45° FOV — 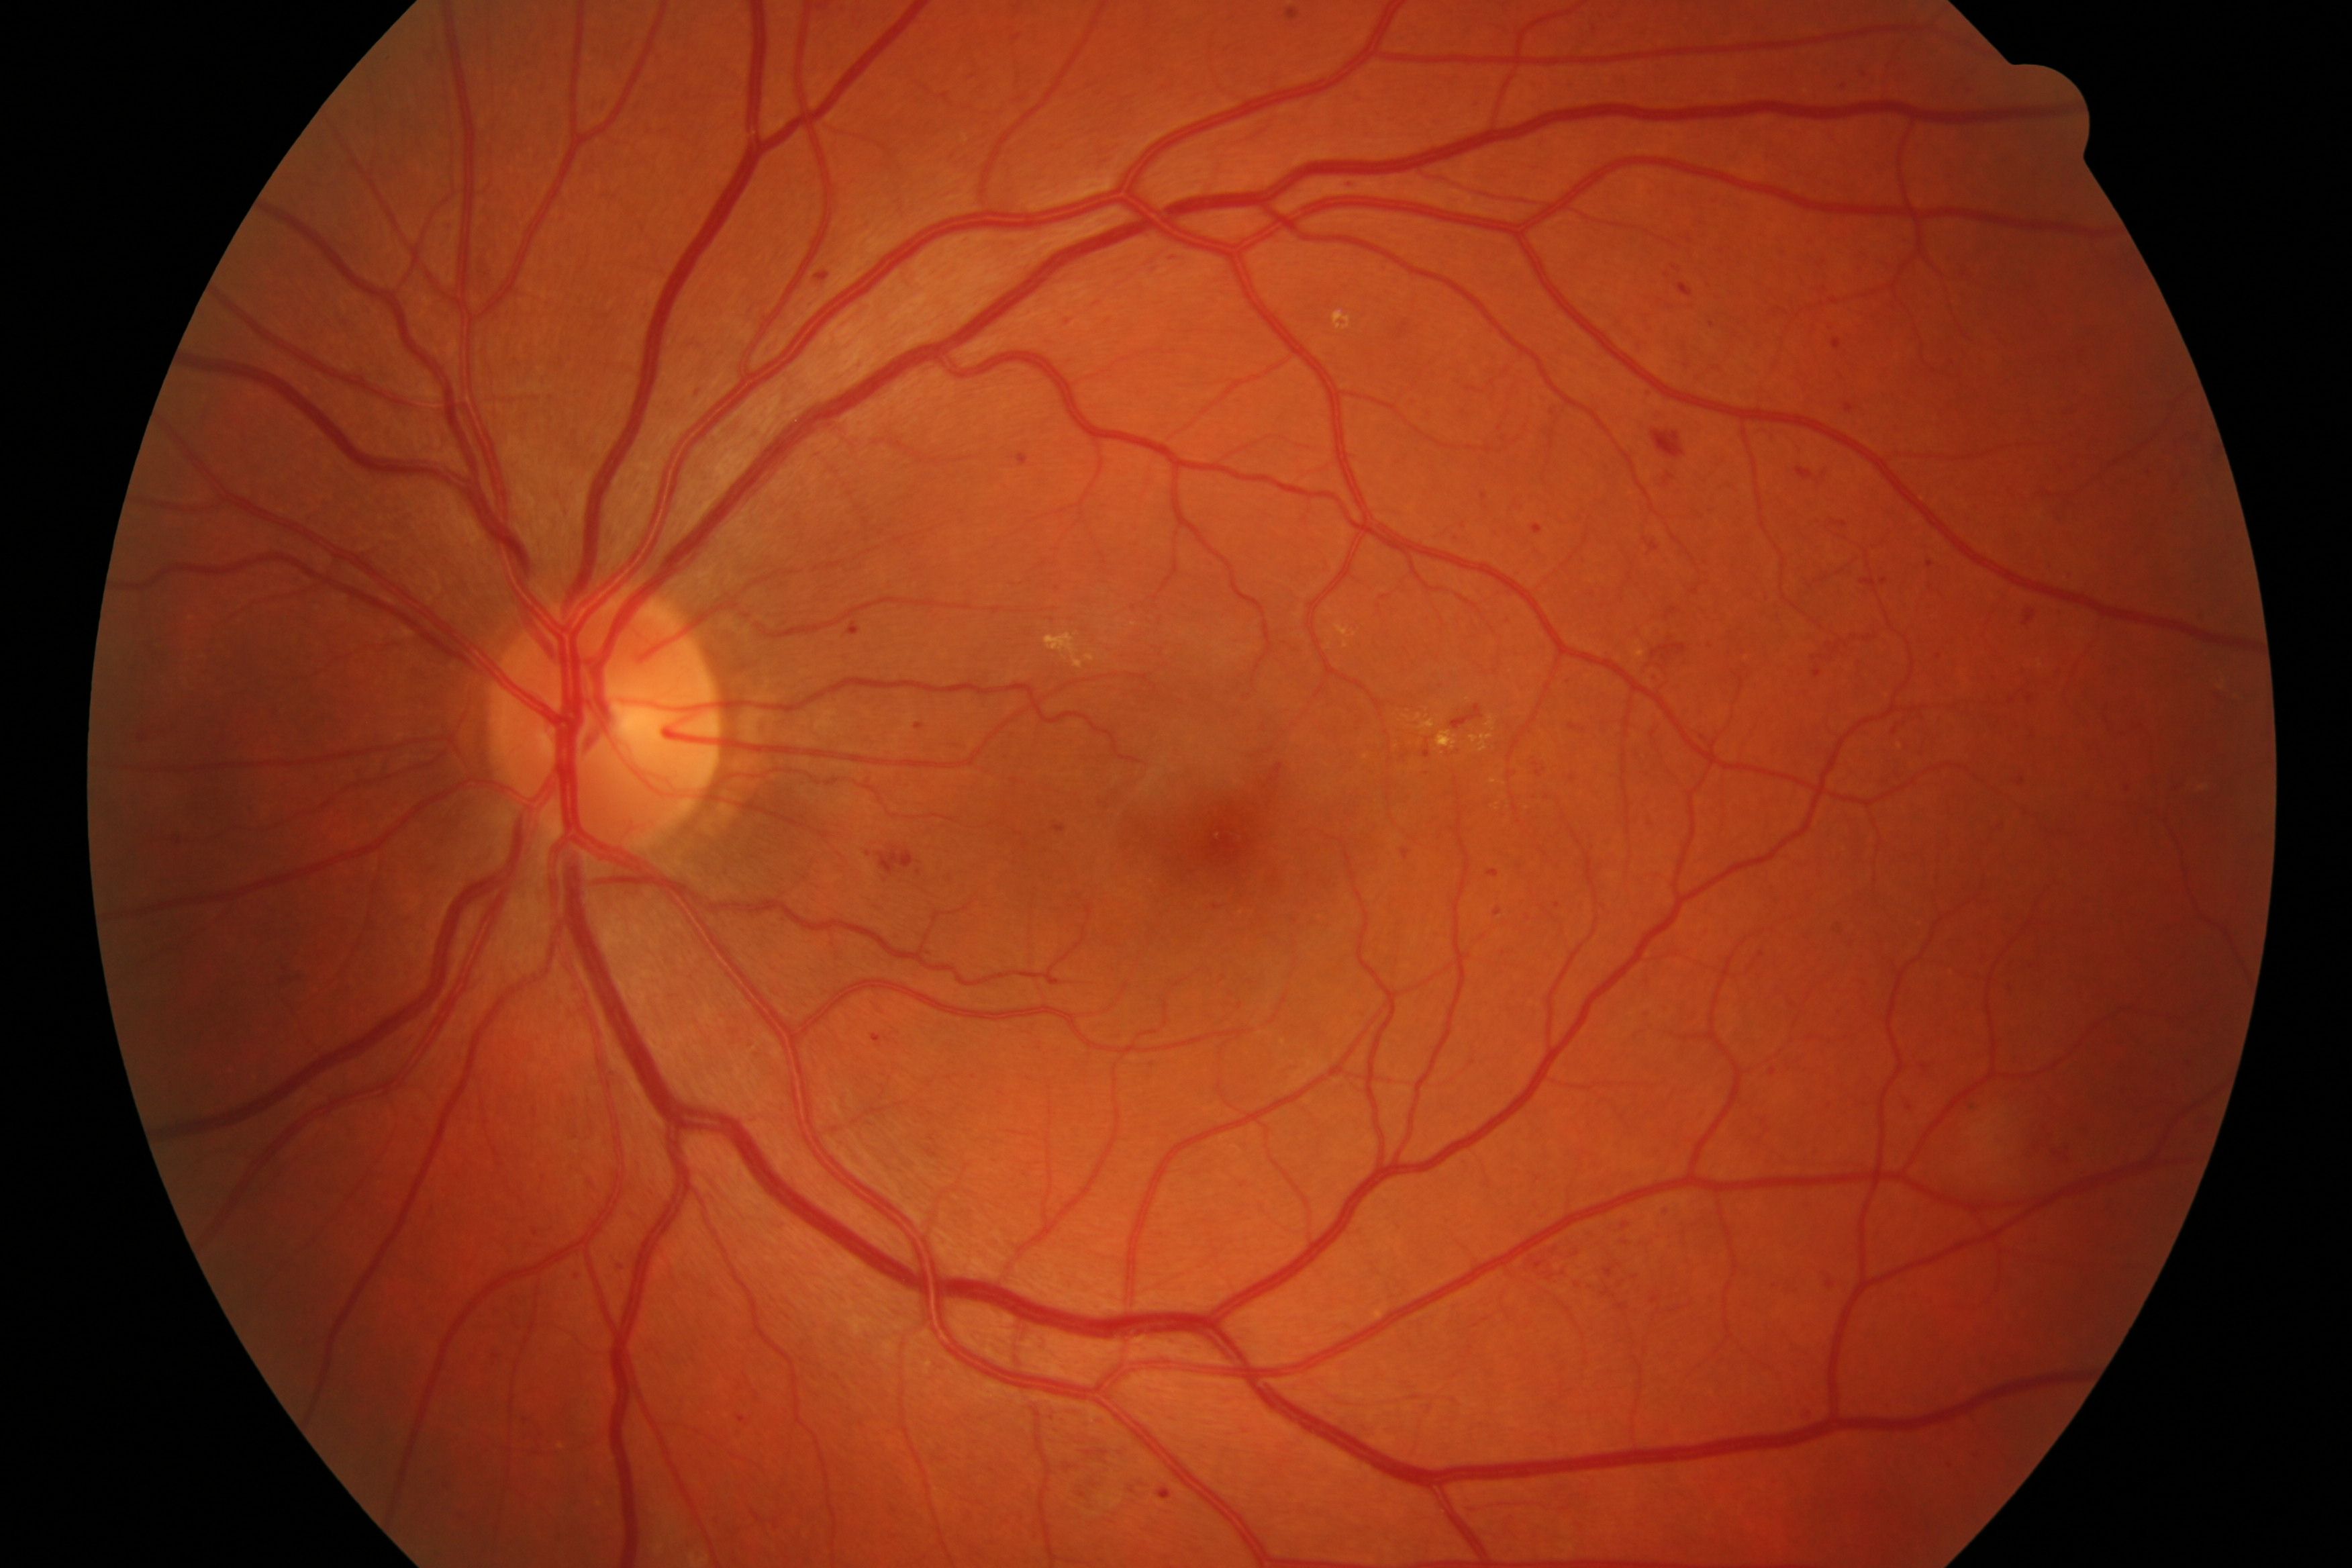
Assessment: diabetic retinopathy (DR).